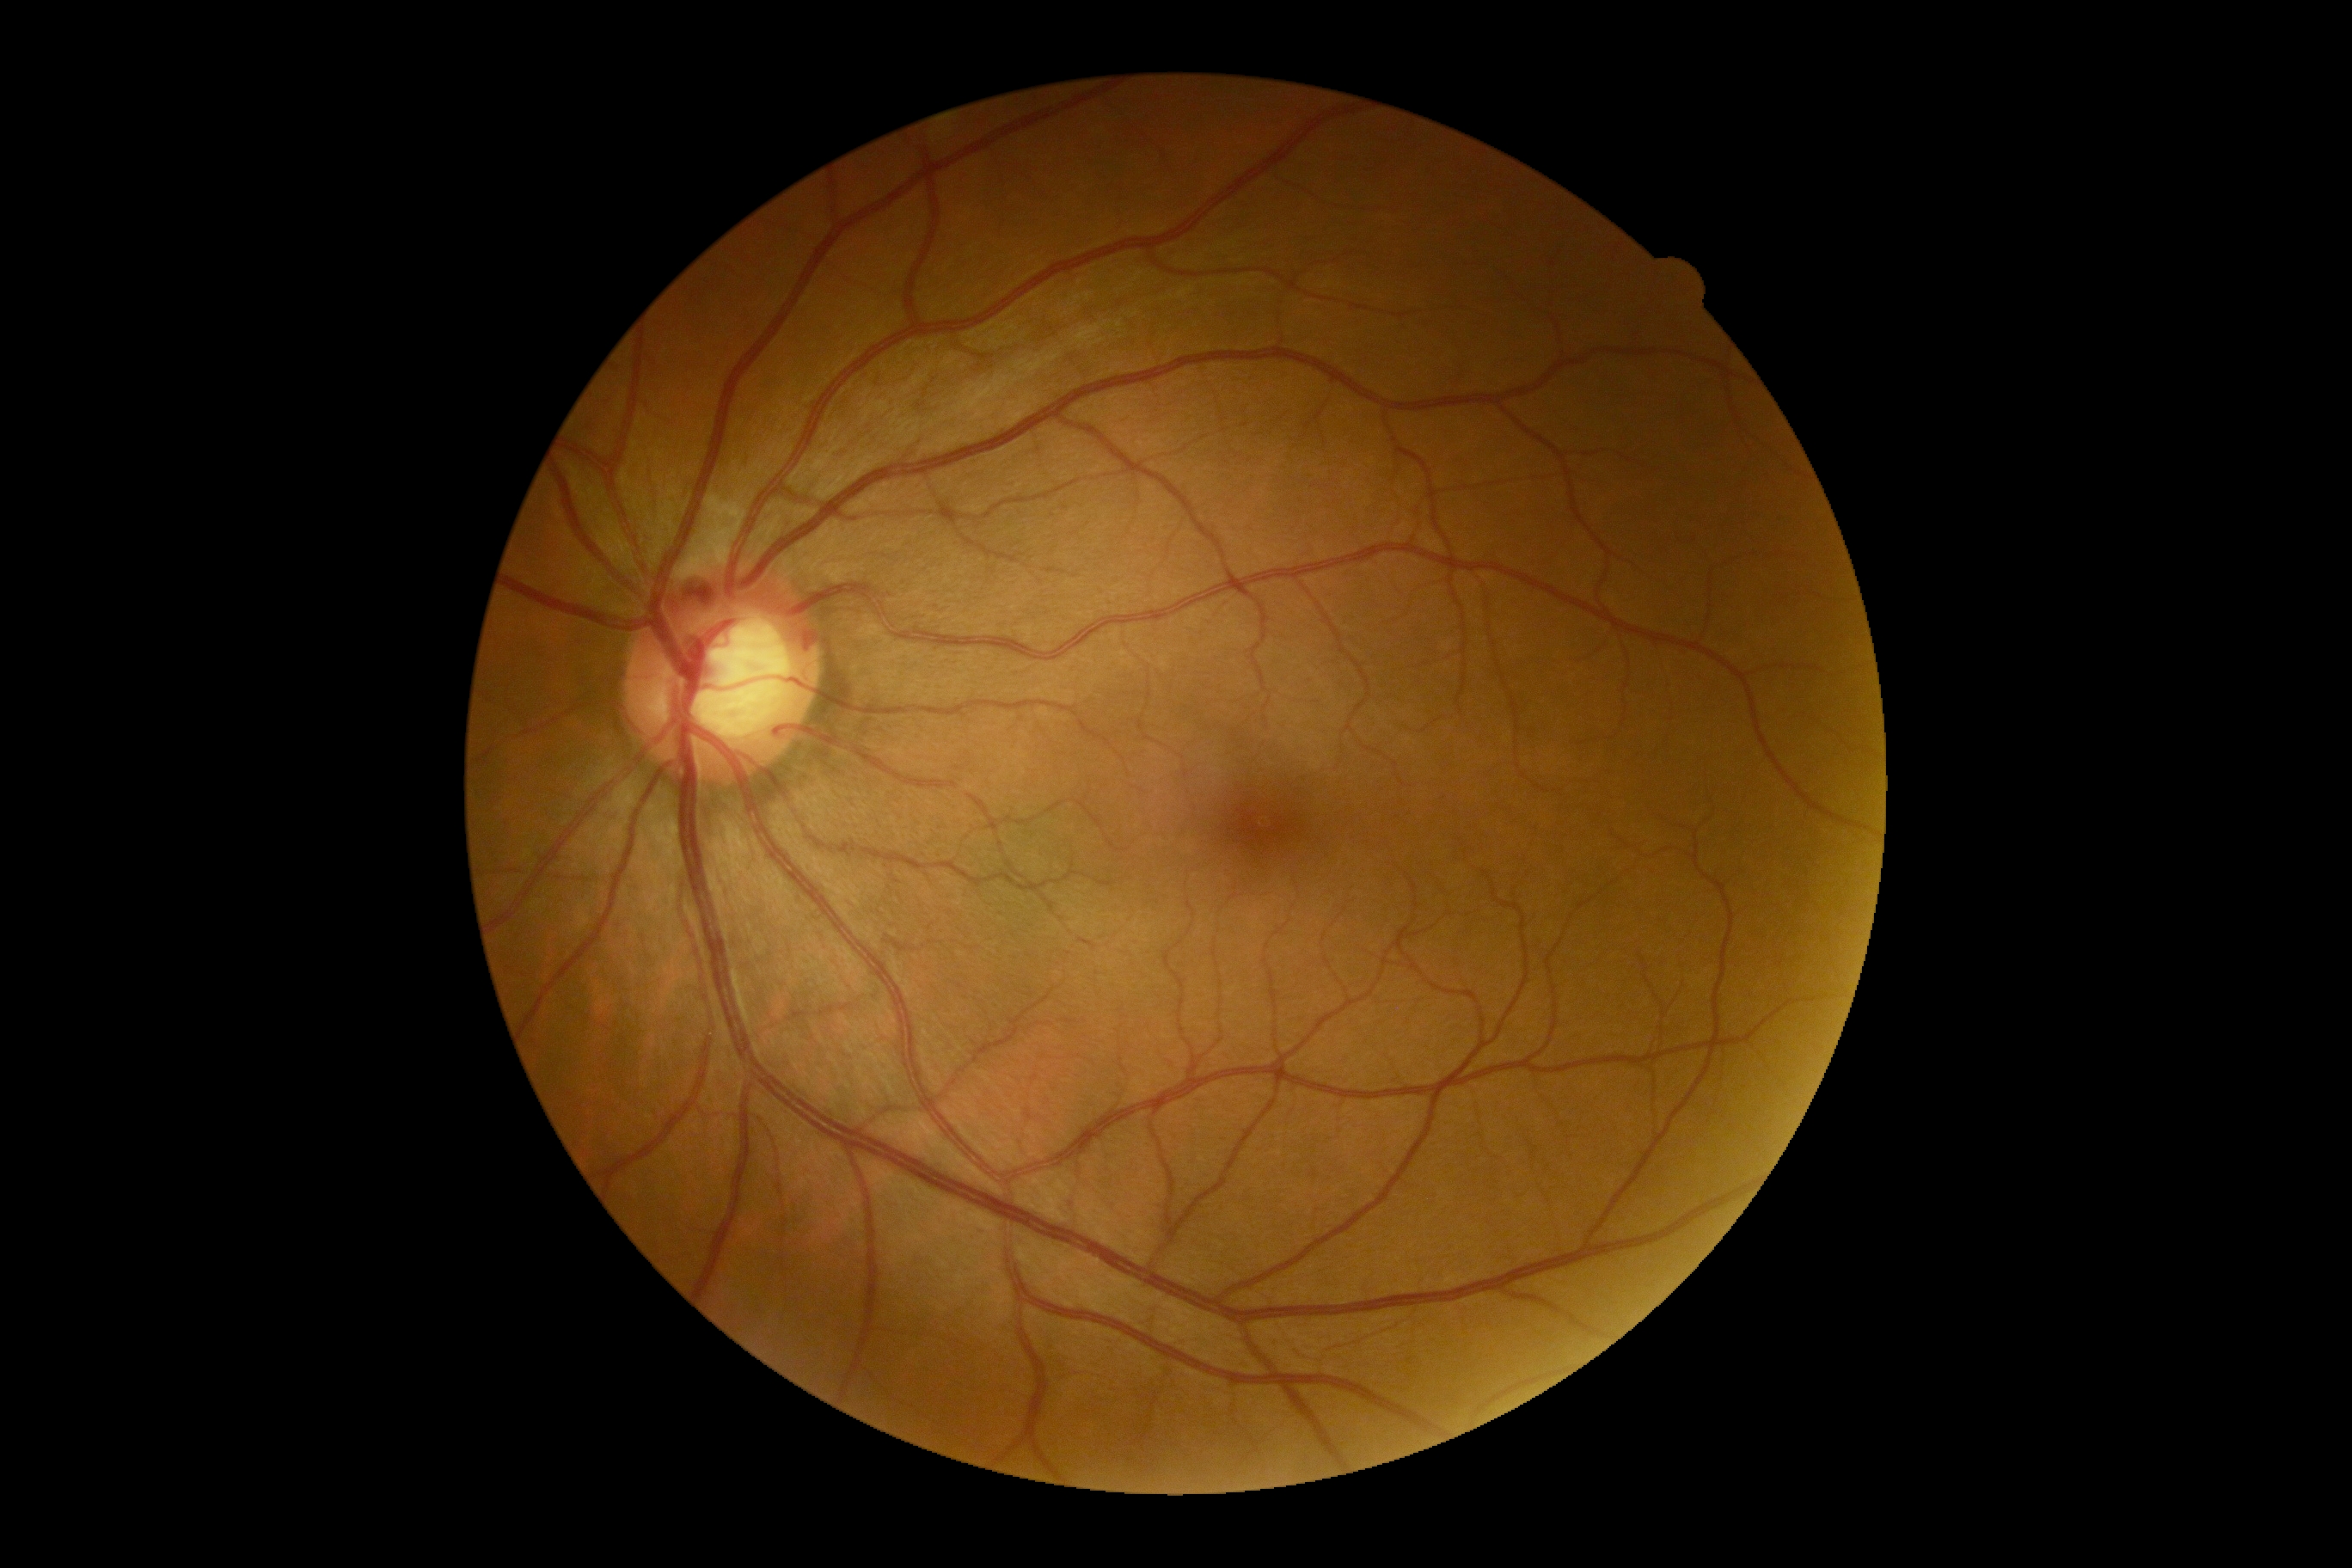
The retinopathy is classified as non-proliferative diabetic retinopathy. Diabetic retinopathy (DR) is grade 2.